Color fundus photograph · 2352 x 1568 pixels.
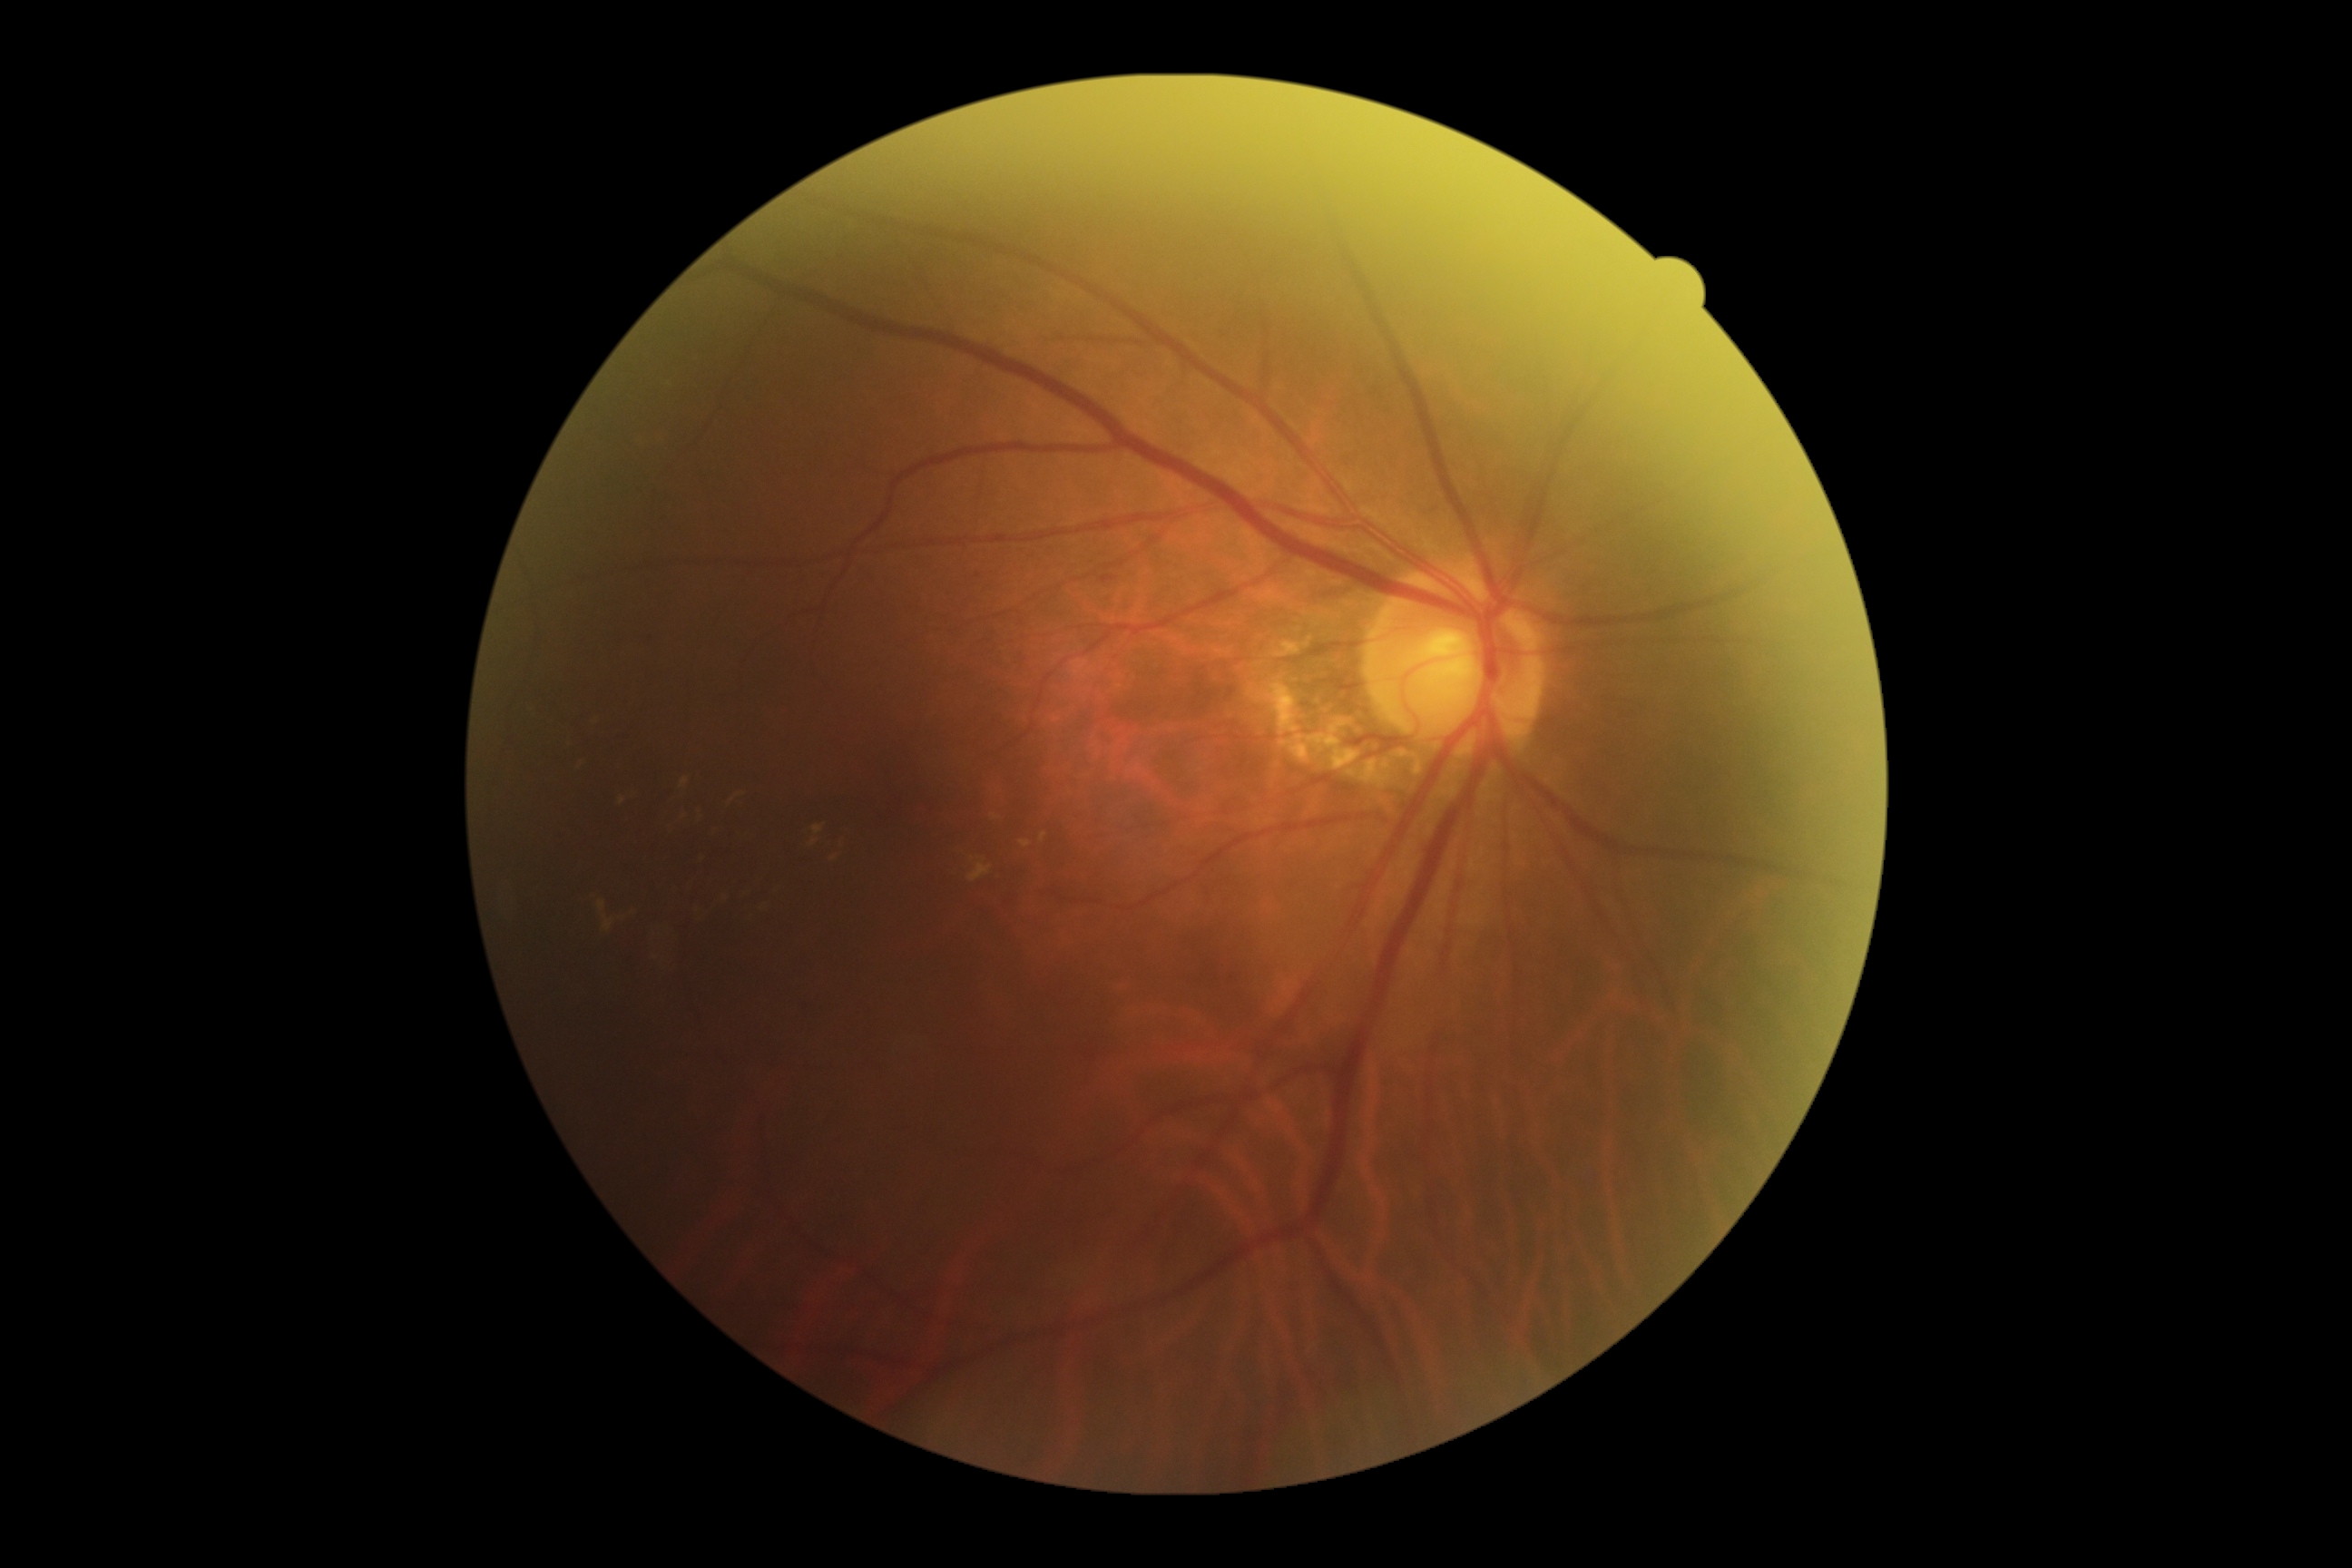 DR: grade 2.